45-degree field of view
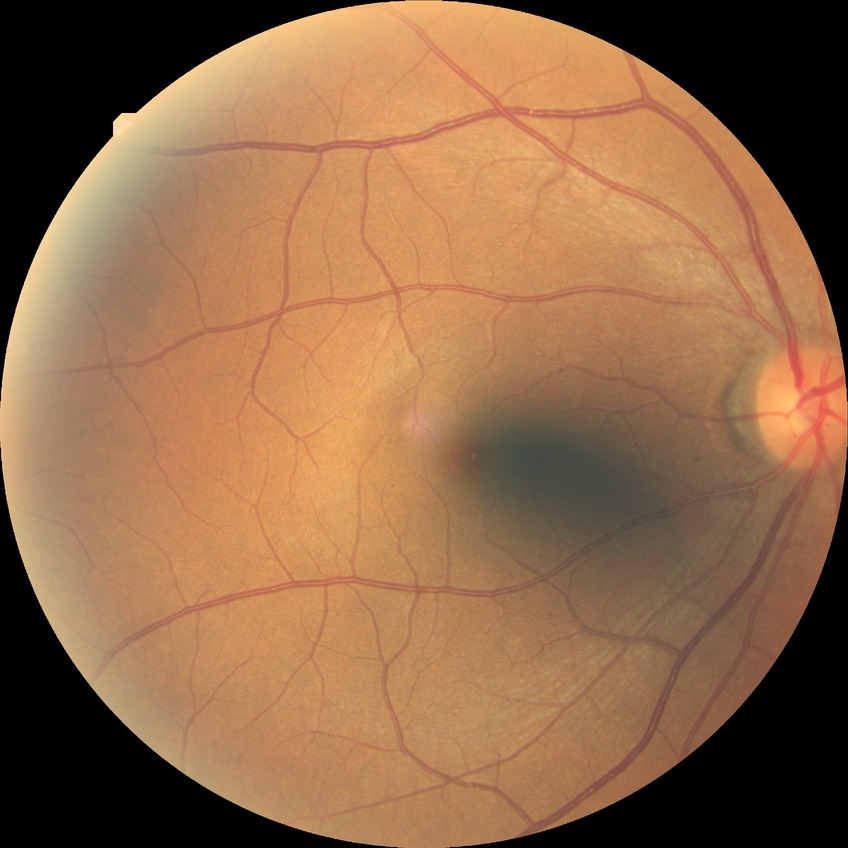 Assessment:
• DR stage — SDR
• DR class — non-proliferative diabetic retinopathy